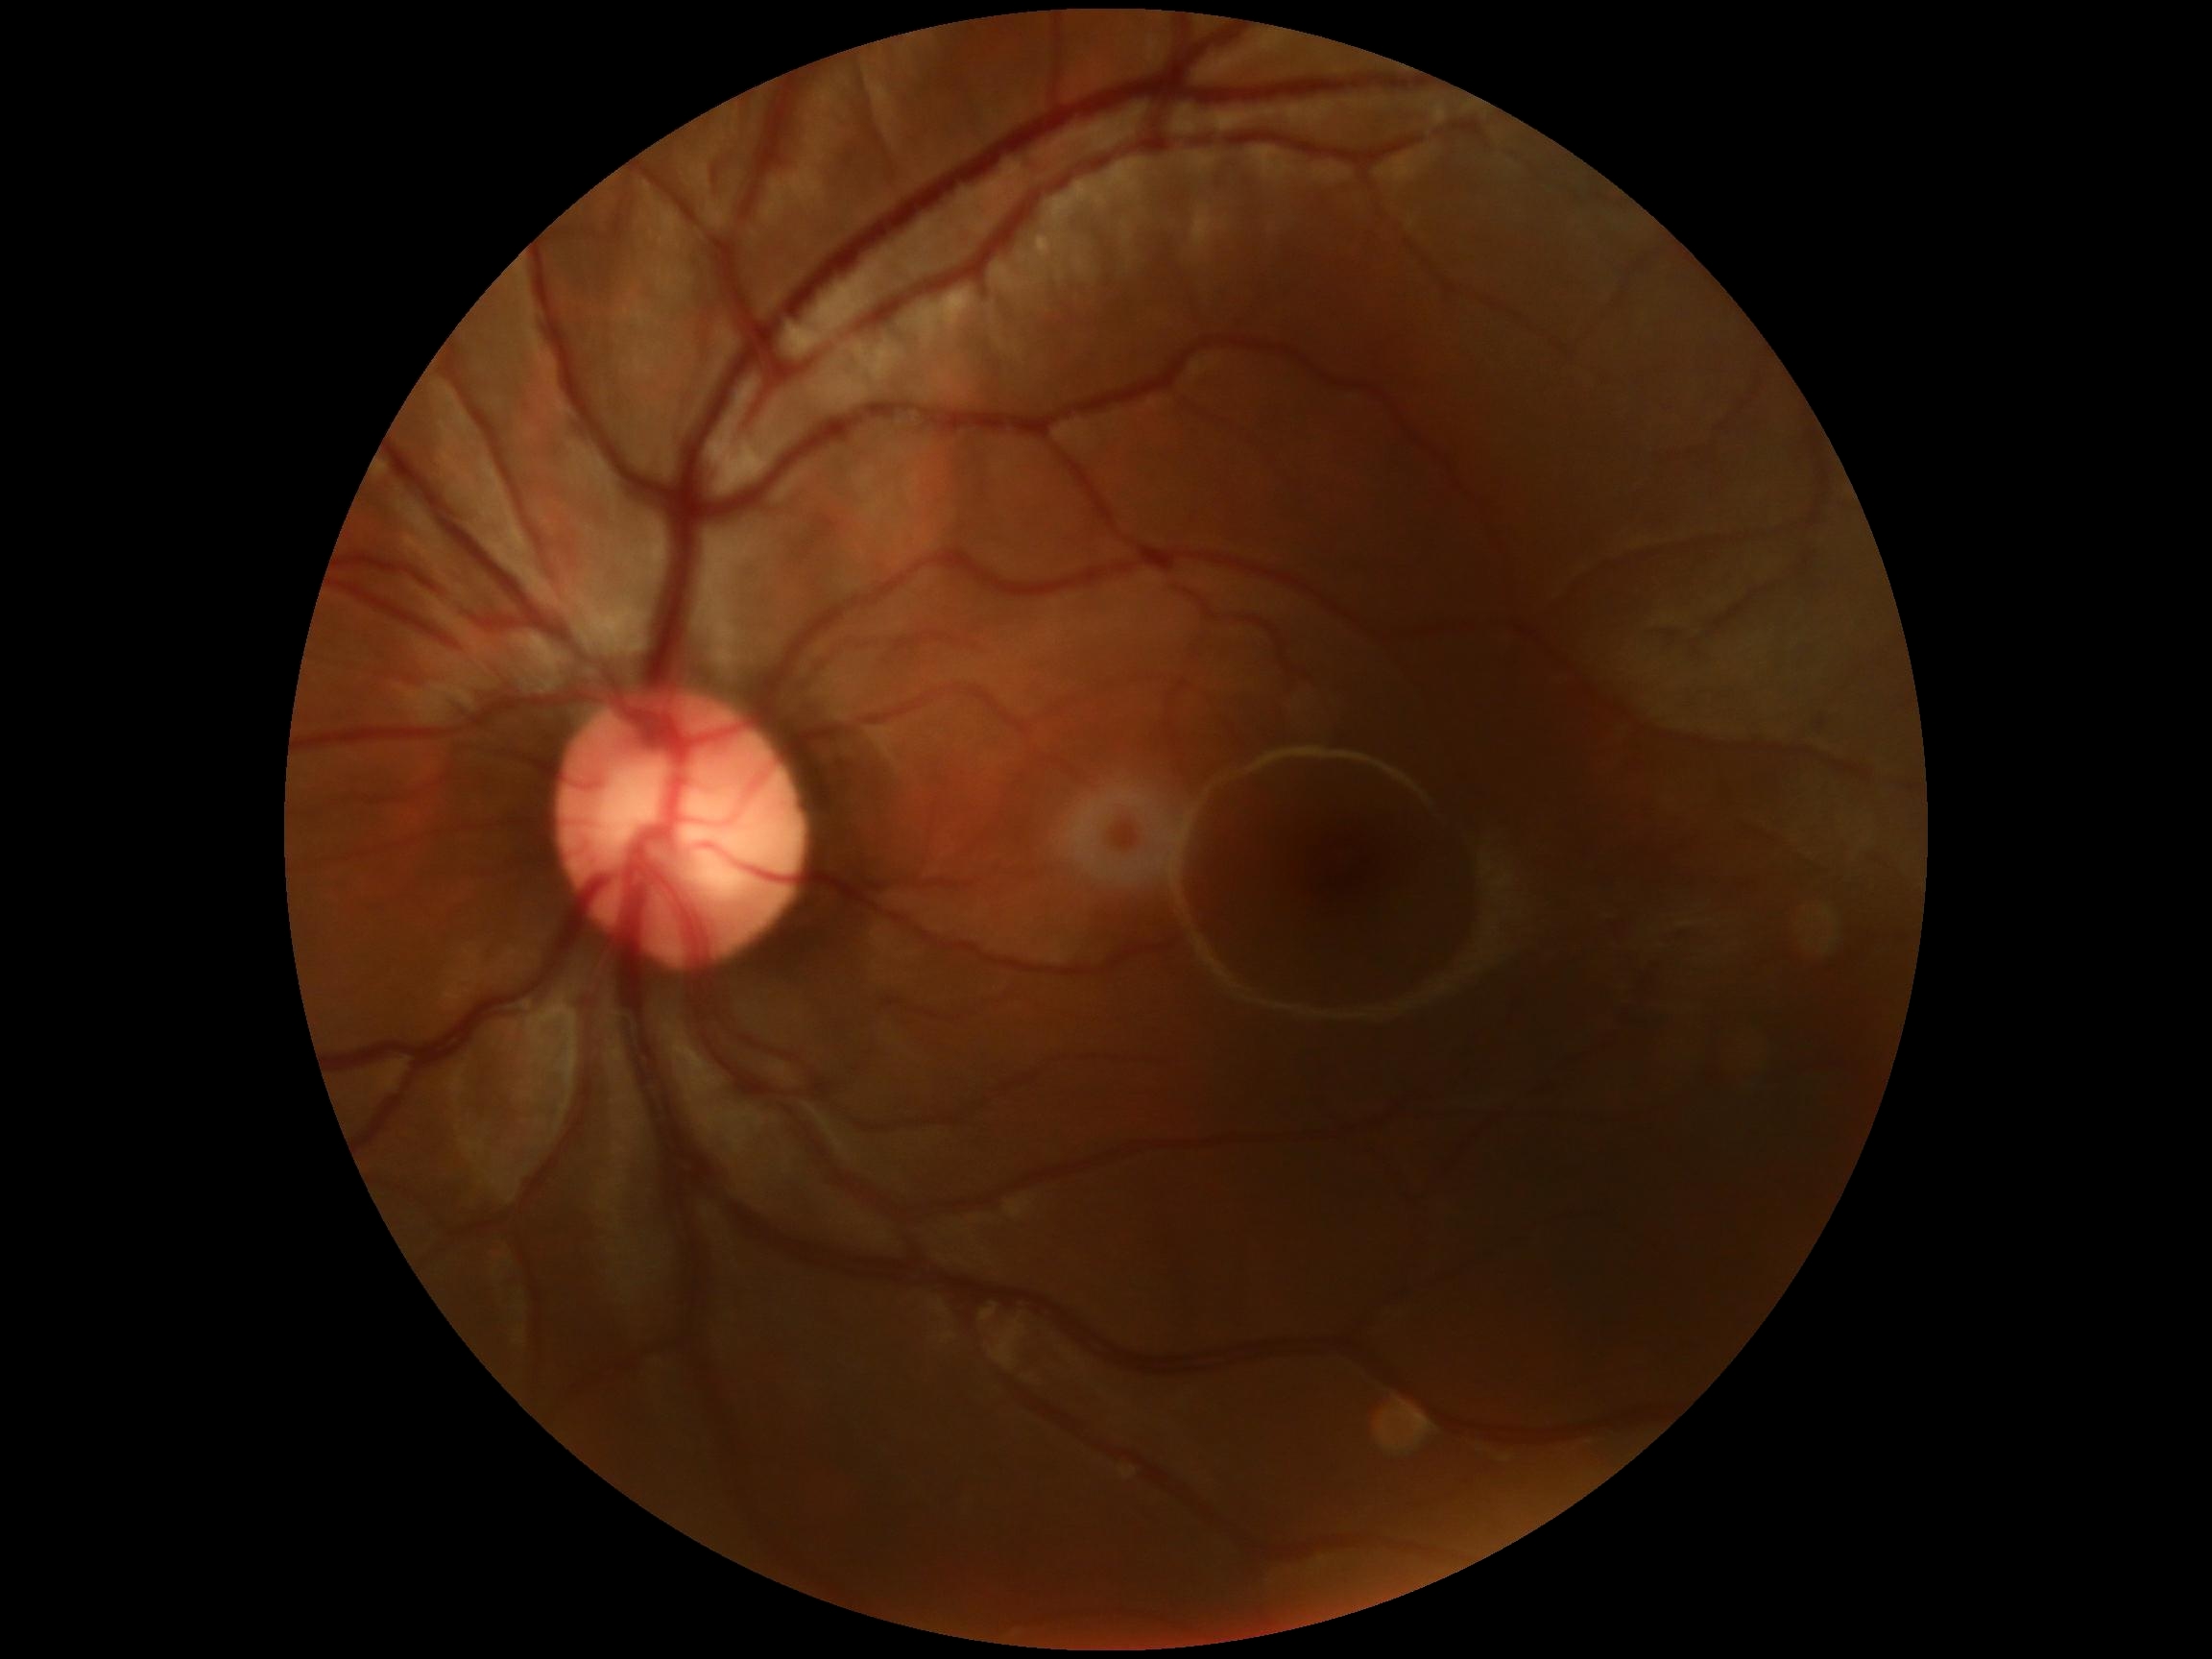 {
  "dr_grade": "0/4 — no visible signs of diabetic retinopathy",
  "dr_impression": "no apparent DR"
}